Posterior pole view, 50° FOV — 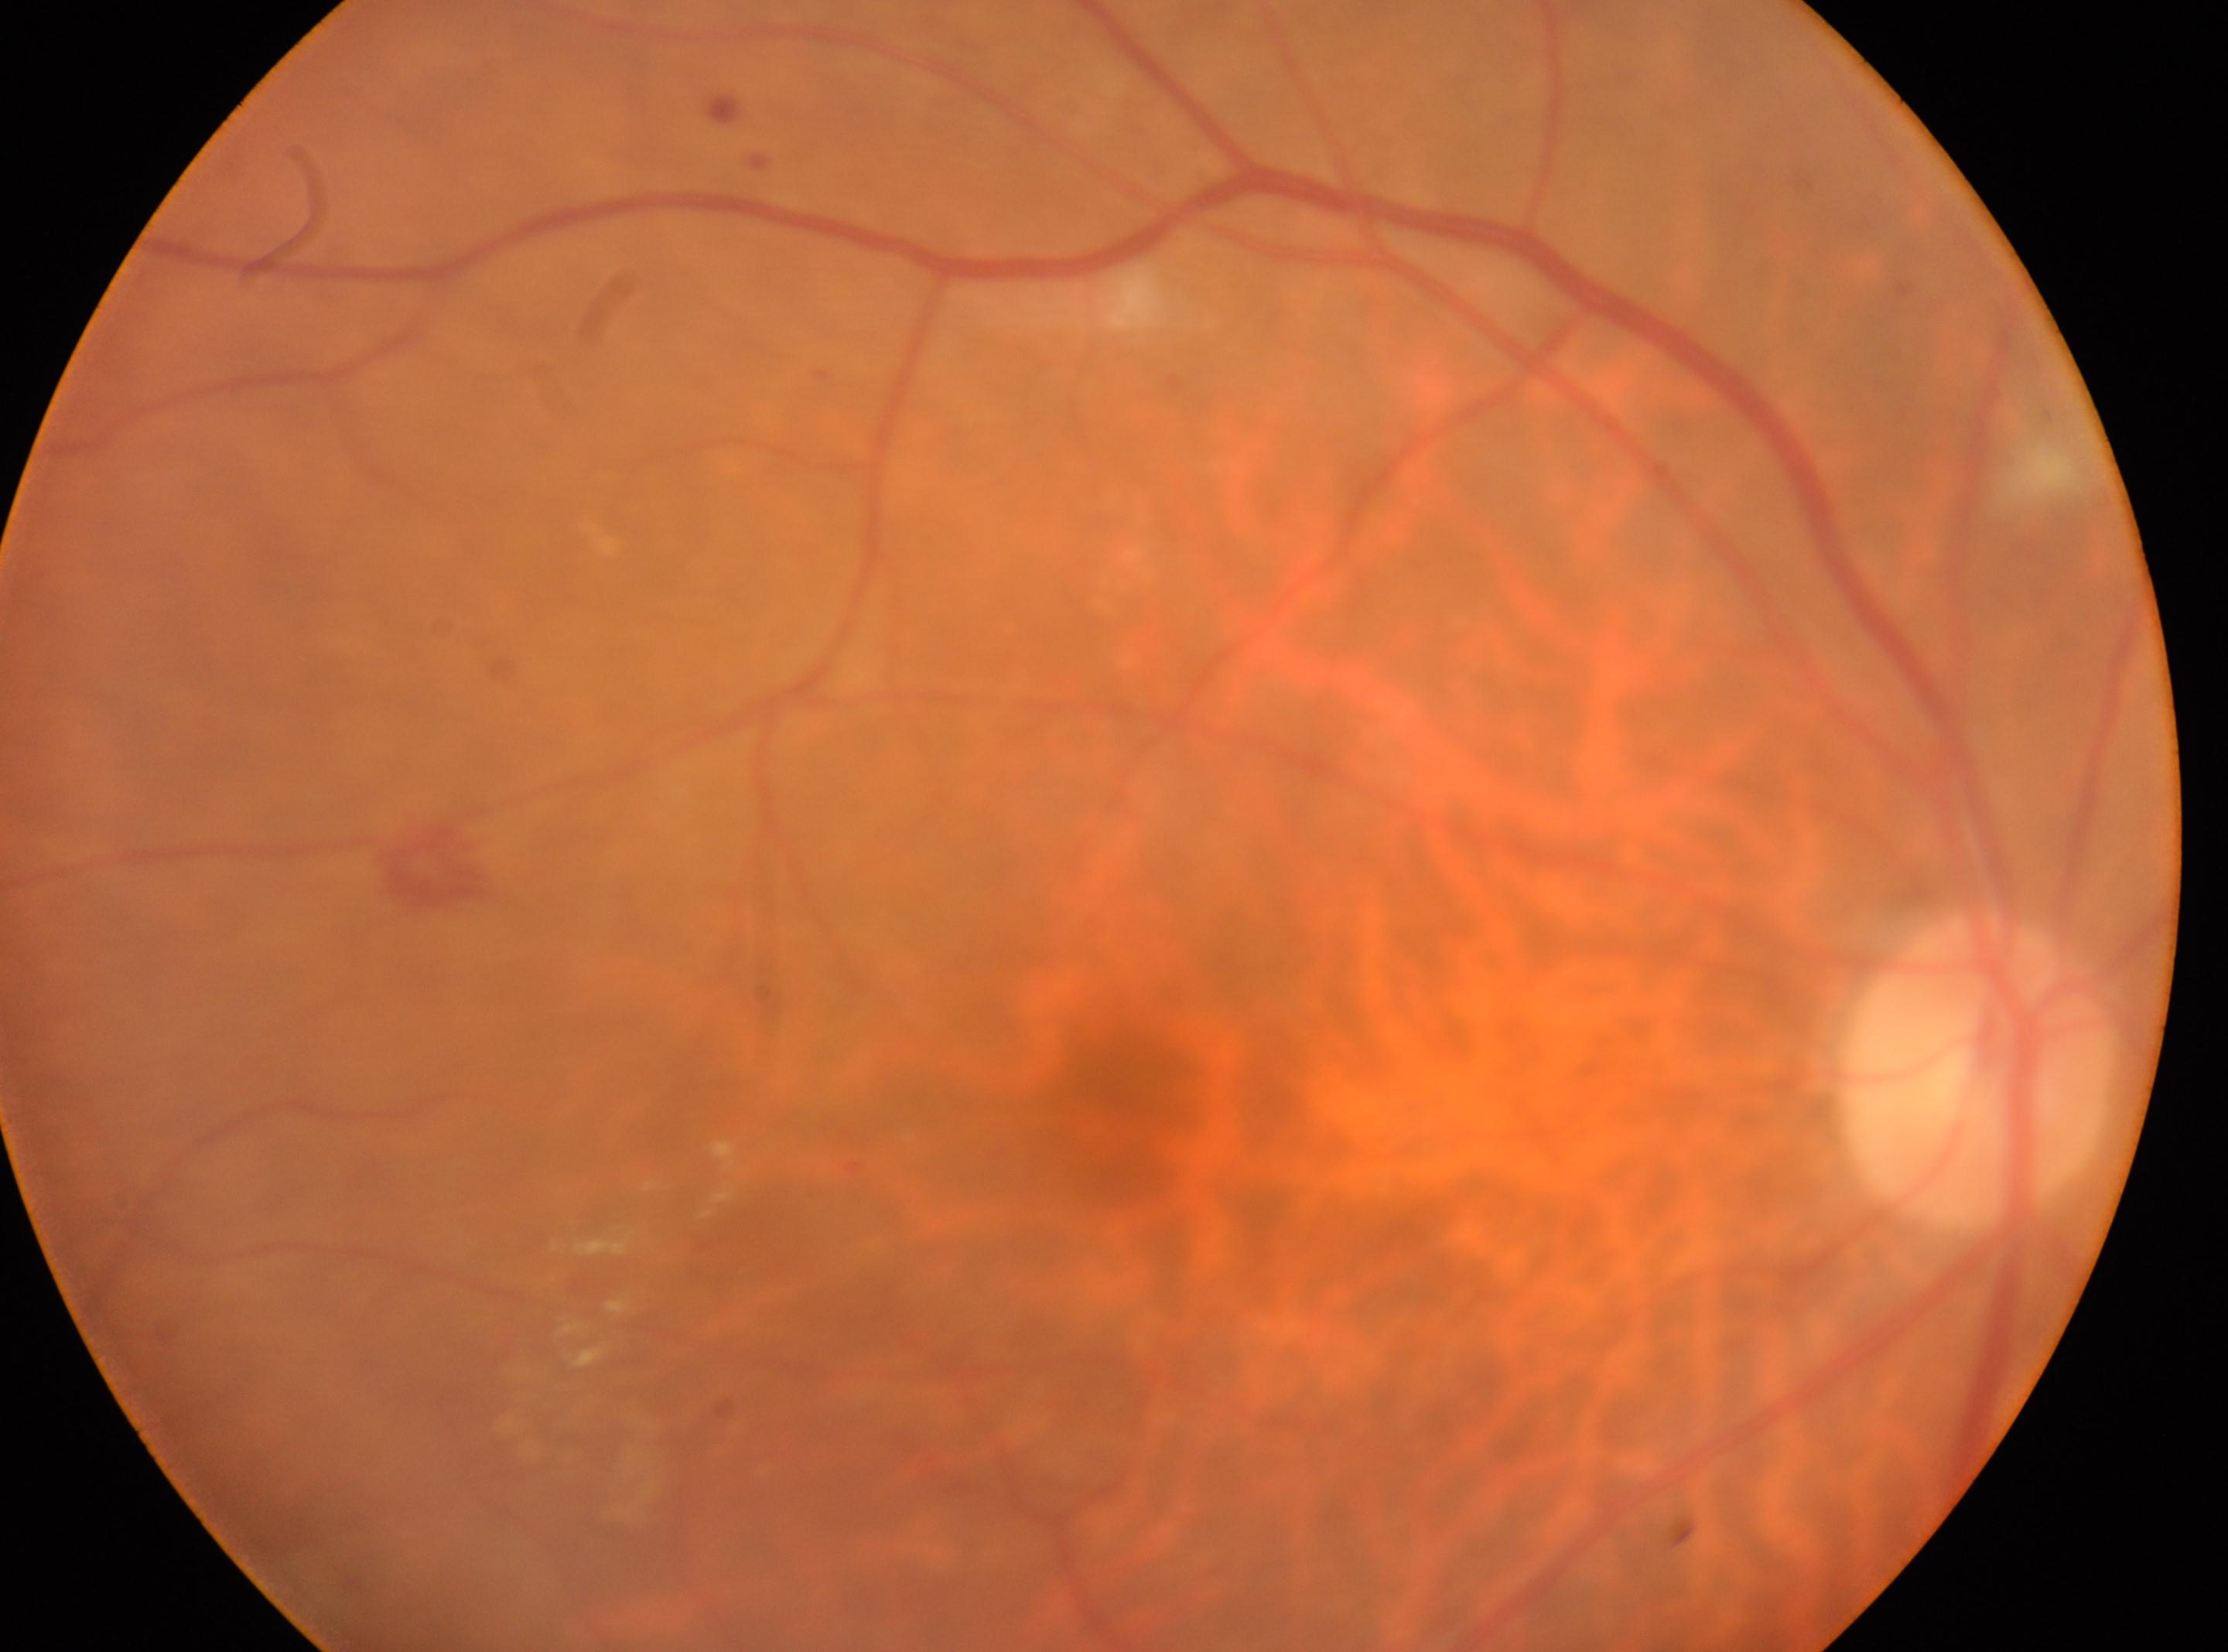
eye = OD
DR stage = 2
macula center = (1137, 1094)
disc center = (1979, 1070)